Infant wide-field fundus photograph
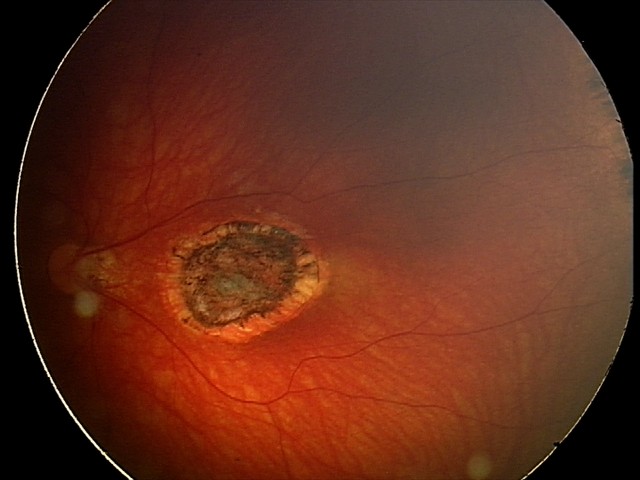 Q: What is the screening diagnosis?
A: toxoplasmosis chorioretinitis